Color fundus photograph · image size 1920x1088 · 45-degree field of view
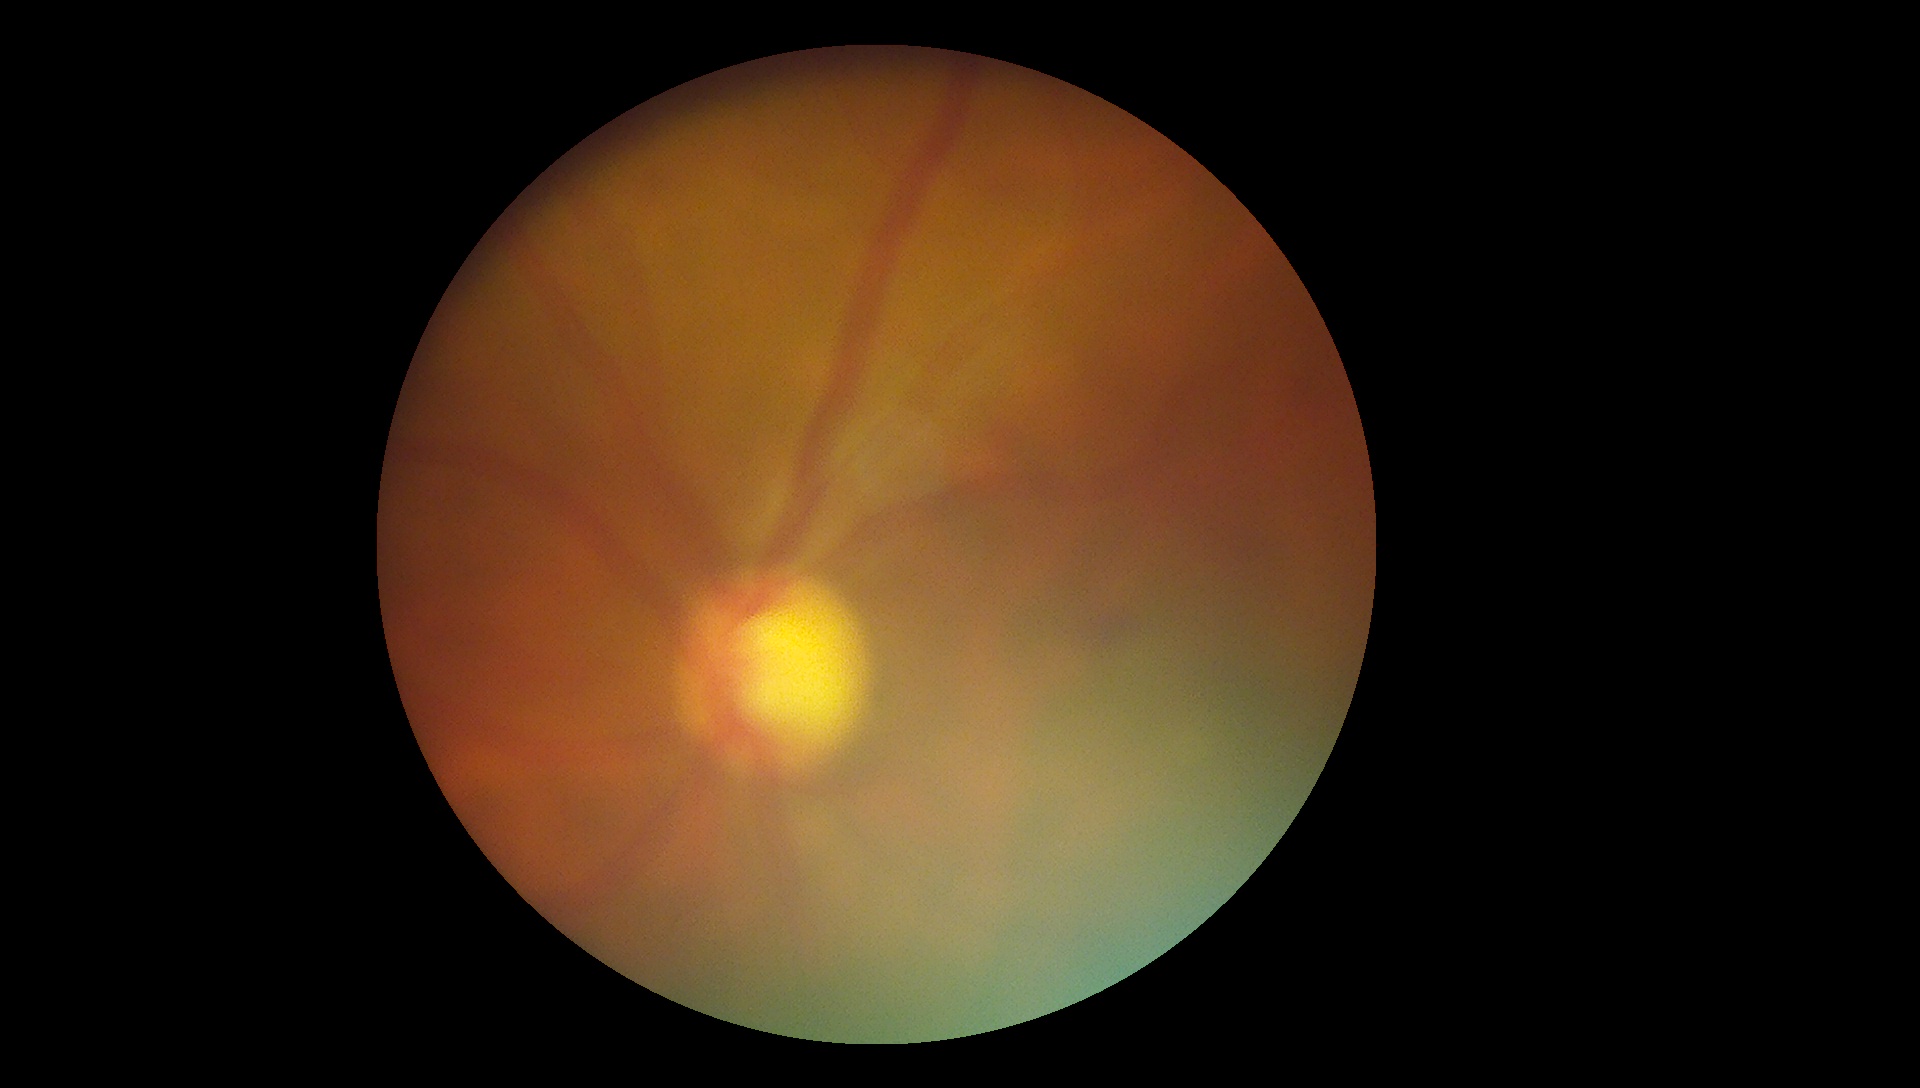
Diabetic retinopathy grade is moderate NPDR (2).